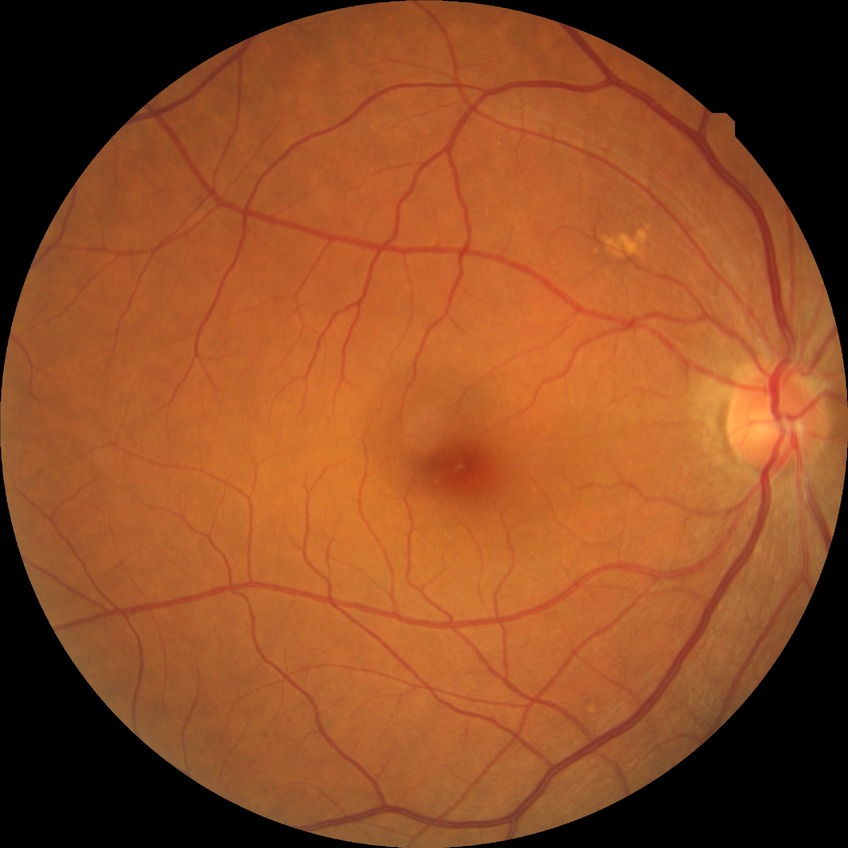 Assessment:
* retinopathy grade: no diabetic retinopathy